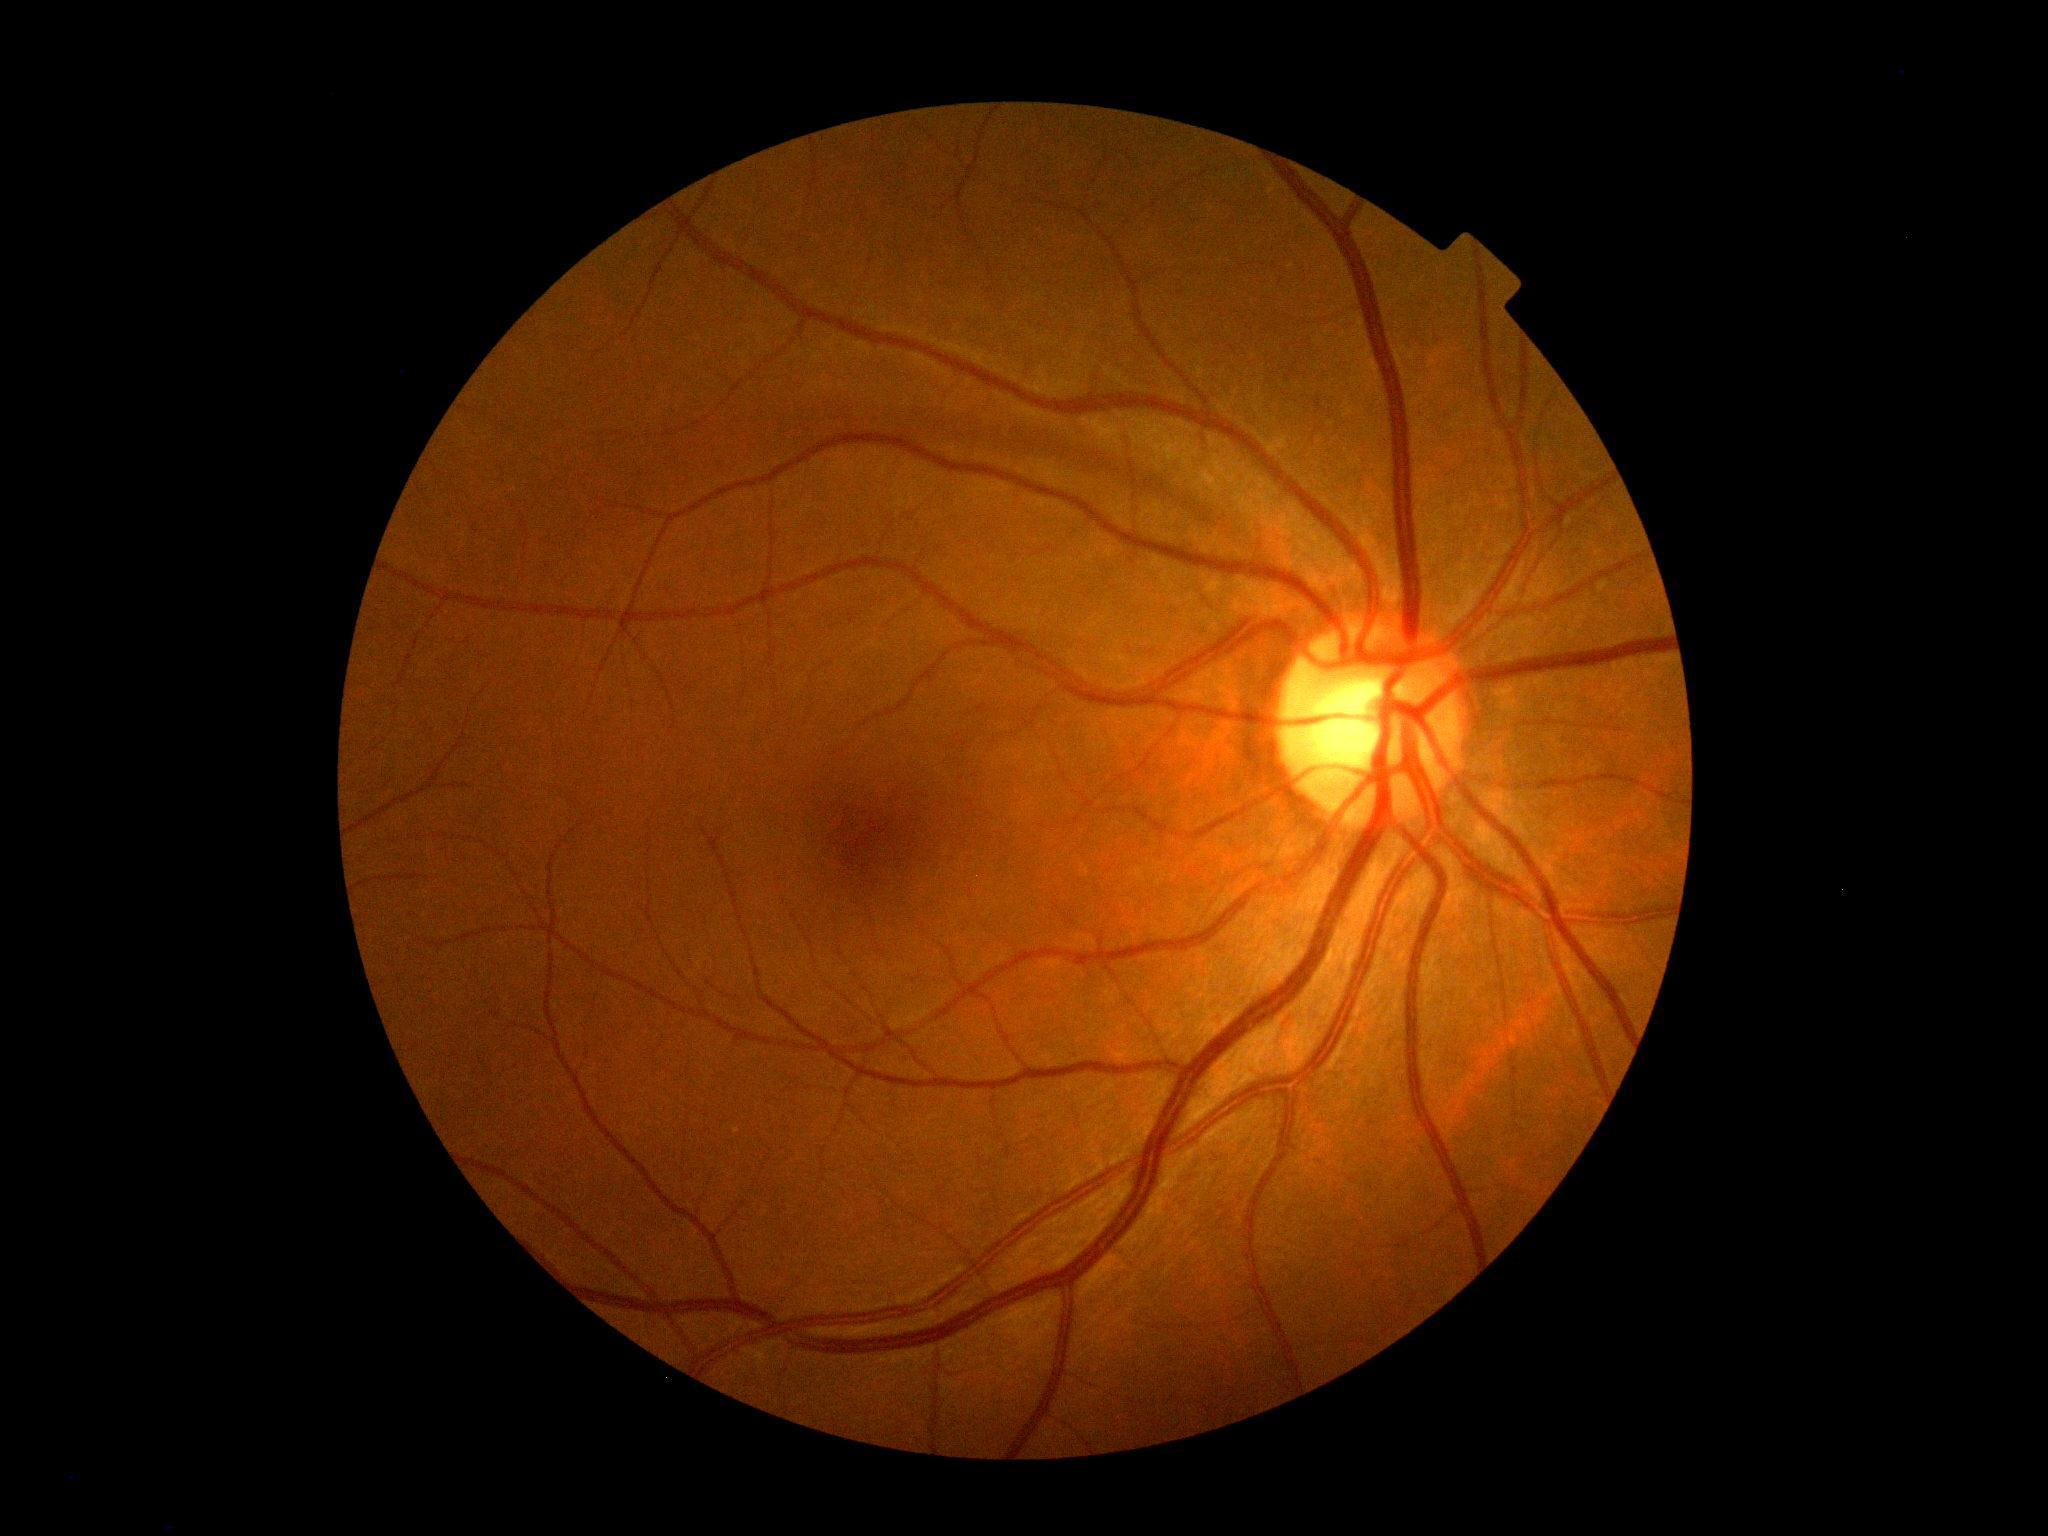

DR stage is 0/4.